Infant wide-field fundus photograph — 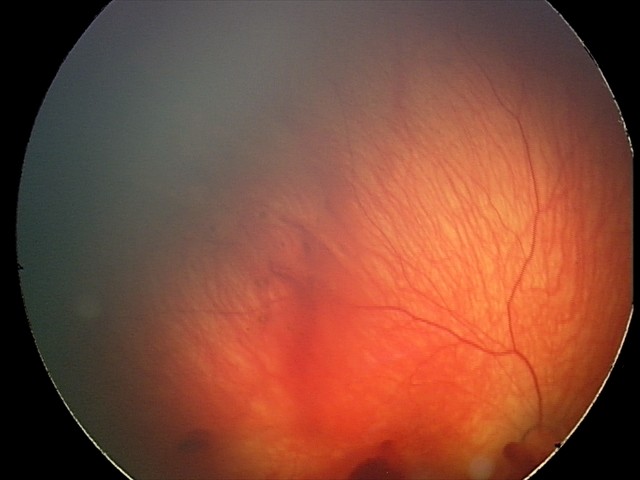
Impression: retinal hemorrhages.